Image size 2352x1568, FOV: 45 degrees, fundus photo:
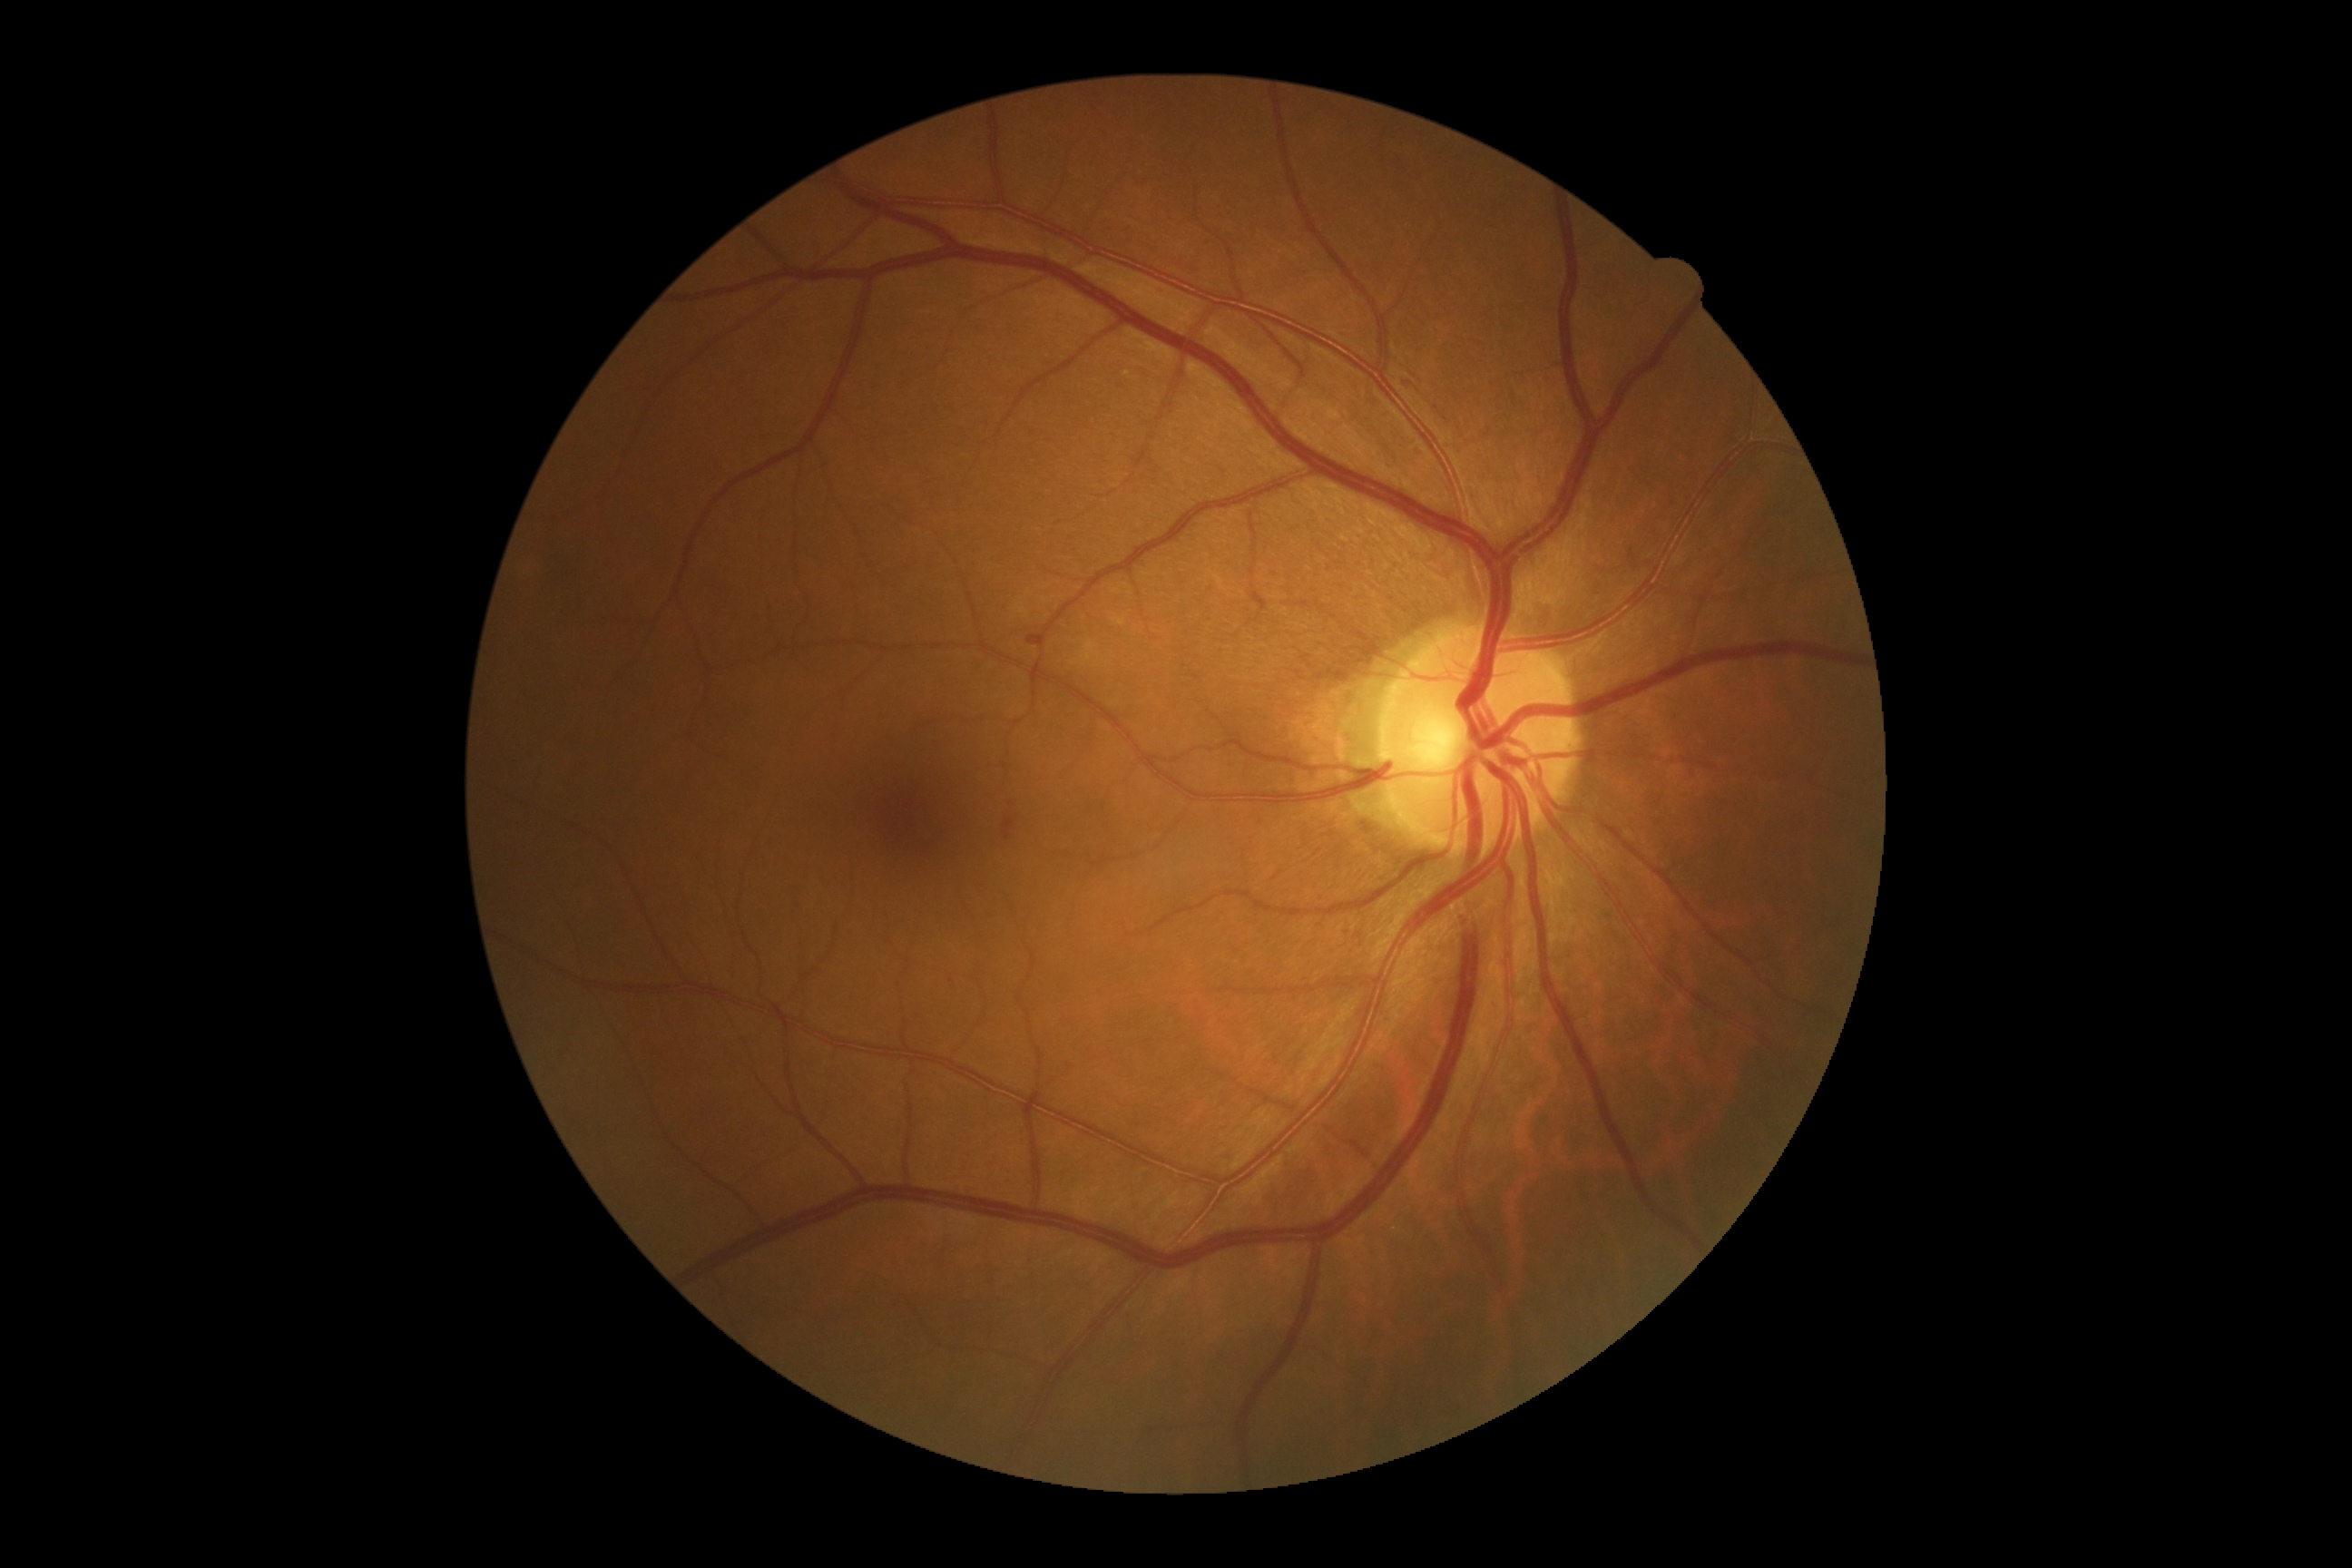 diabetic retinopathy (DR)=2.